Modified Davis classification.
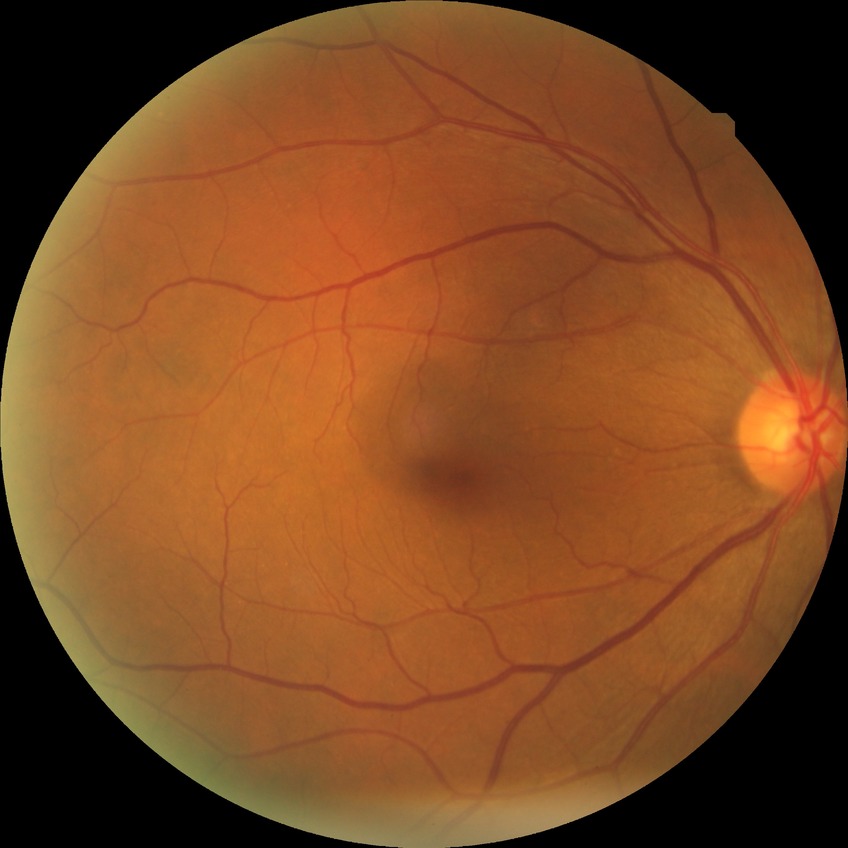

• Davis stage — SDR